45° field of view; retinal fundus photograph — 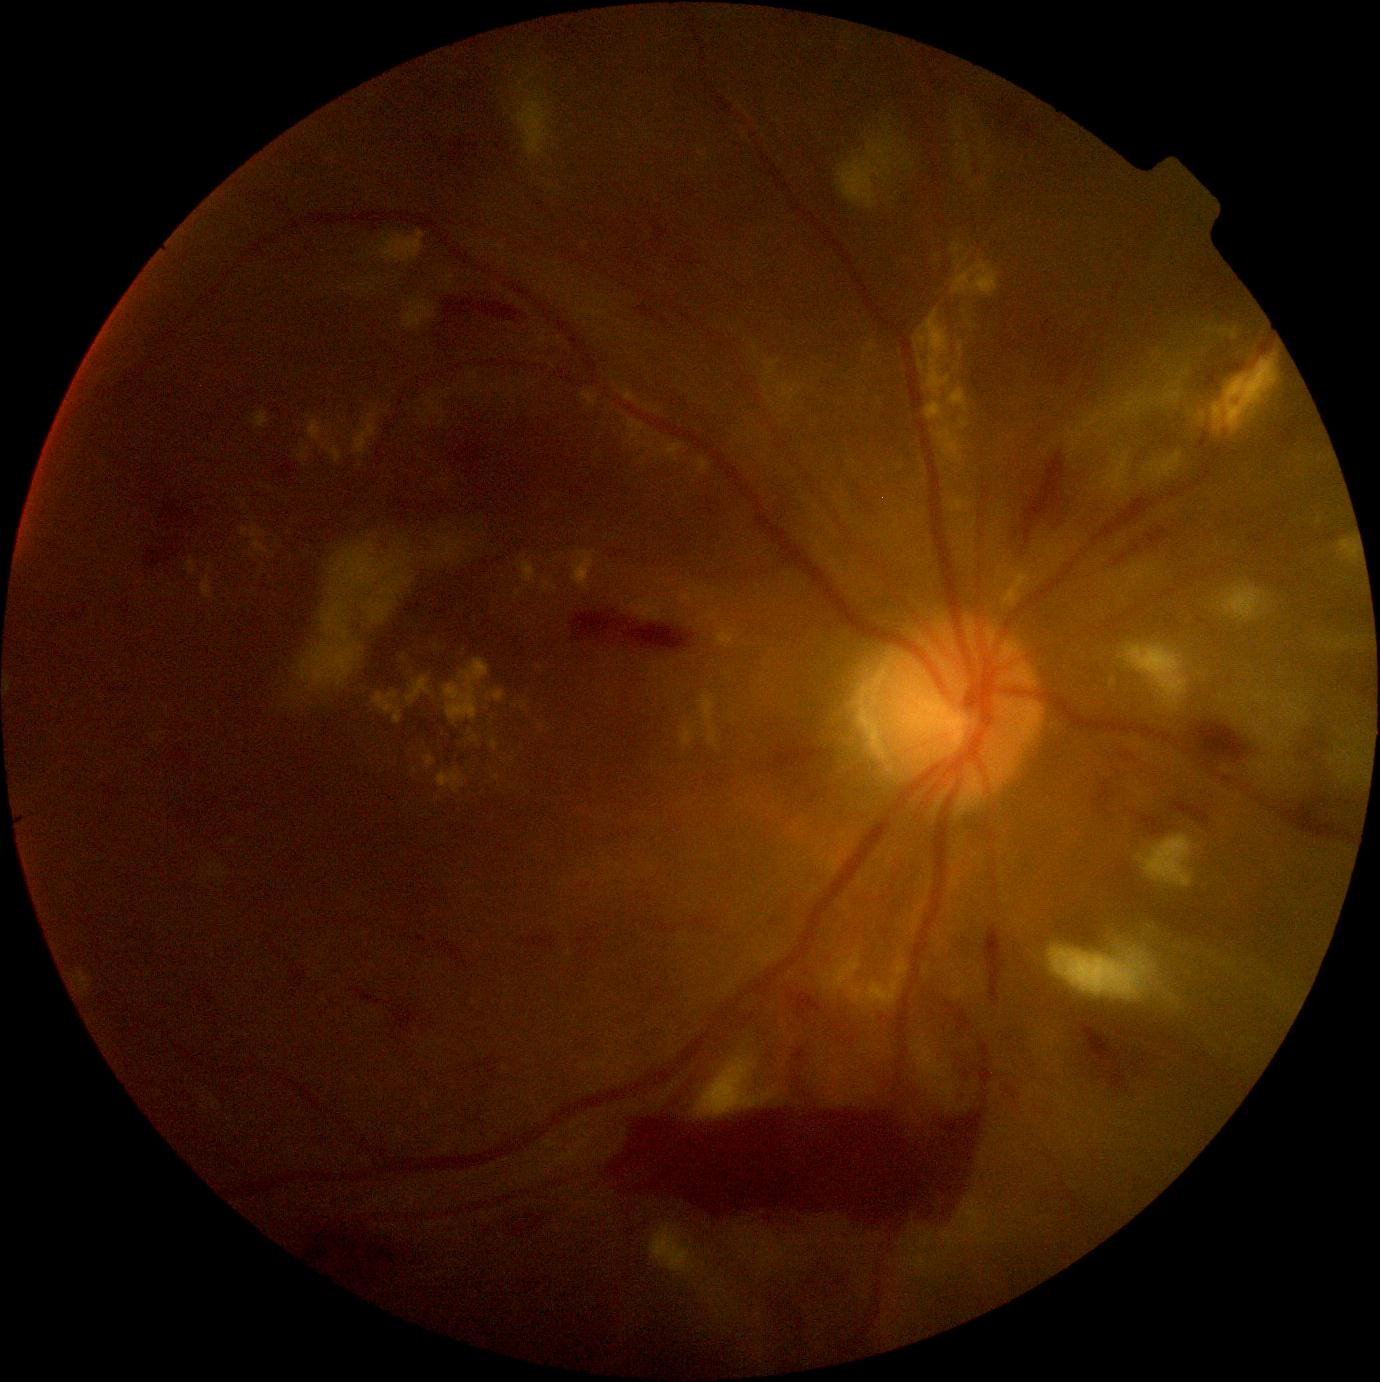
DR stage is PDR (grade 4)
A subset of detected lesions:
EXs (partial): <bbox>959, 418, 970, 431</bbox>, <bbox>486, 691, 505, 703</bbox>, <bbox>353, 414, 378, 457</bbox>, <bbox>665, 443, 683, 460</bbox>, <bbox>327, 447, 343, 464</bbox>, <bbox>492, 740, 498, 750</bbox>, <bbox>701, 696, 718, 749</bbox>, <bbox>543, 583, 558, 594</bbox>, <bbox>517, 556, 537, 590</bbox>, <bbox>443, 658, 490, 724</bbox>, <bbox>919, 362, 924, 371</bbox>
EXs (small, approximate centers) near (x=325, y=446), (x=659, y=453), (x=657, y=457), (x=660, y=583), (x=440, y=799)
SEs (partial): <bbox>1101, 453, 1129, 492</bbox>, <bbox>1266, 735, 1279, 747</bbox>, <bbox>651, 1219, 696, 1274</bbox>, <bbox>1327, 637, 1359, 650</bbox>, <bbox>1125, 645, 1188, 703</bbox>, <bbox>527, 71, 536, 83</bbox>, <bbox>1288, 700, 1296, 710</bbox>, <bbox>823, 948, 909, 1009</bbox>, <bbox>1339, 771, 1345, 781</bbox>, <bbox>1085, 413, 1102, 429</bbox>
SEs (small, approximate centers) near (x=1114, y=415), (x=1187, y=372), (x=886, y=180), (x=1325, y=640), (x=1223, y=698), (x=1099, y=433), (x=1256, y=764)